Fundus photo; 45° FOV.
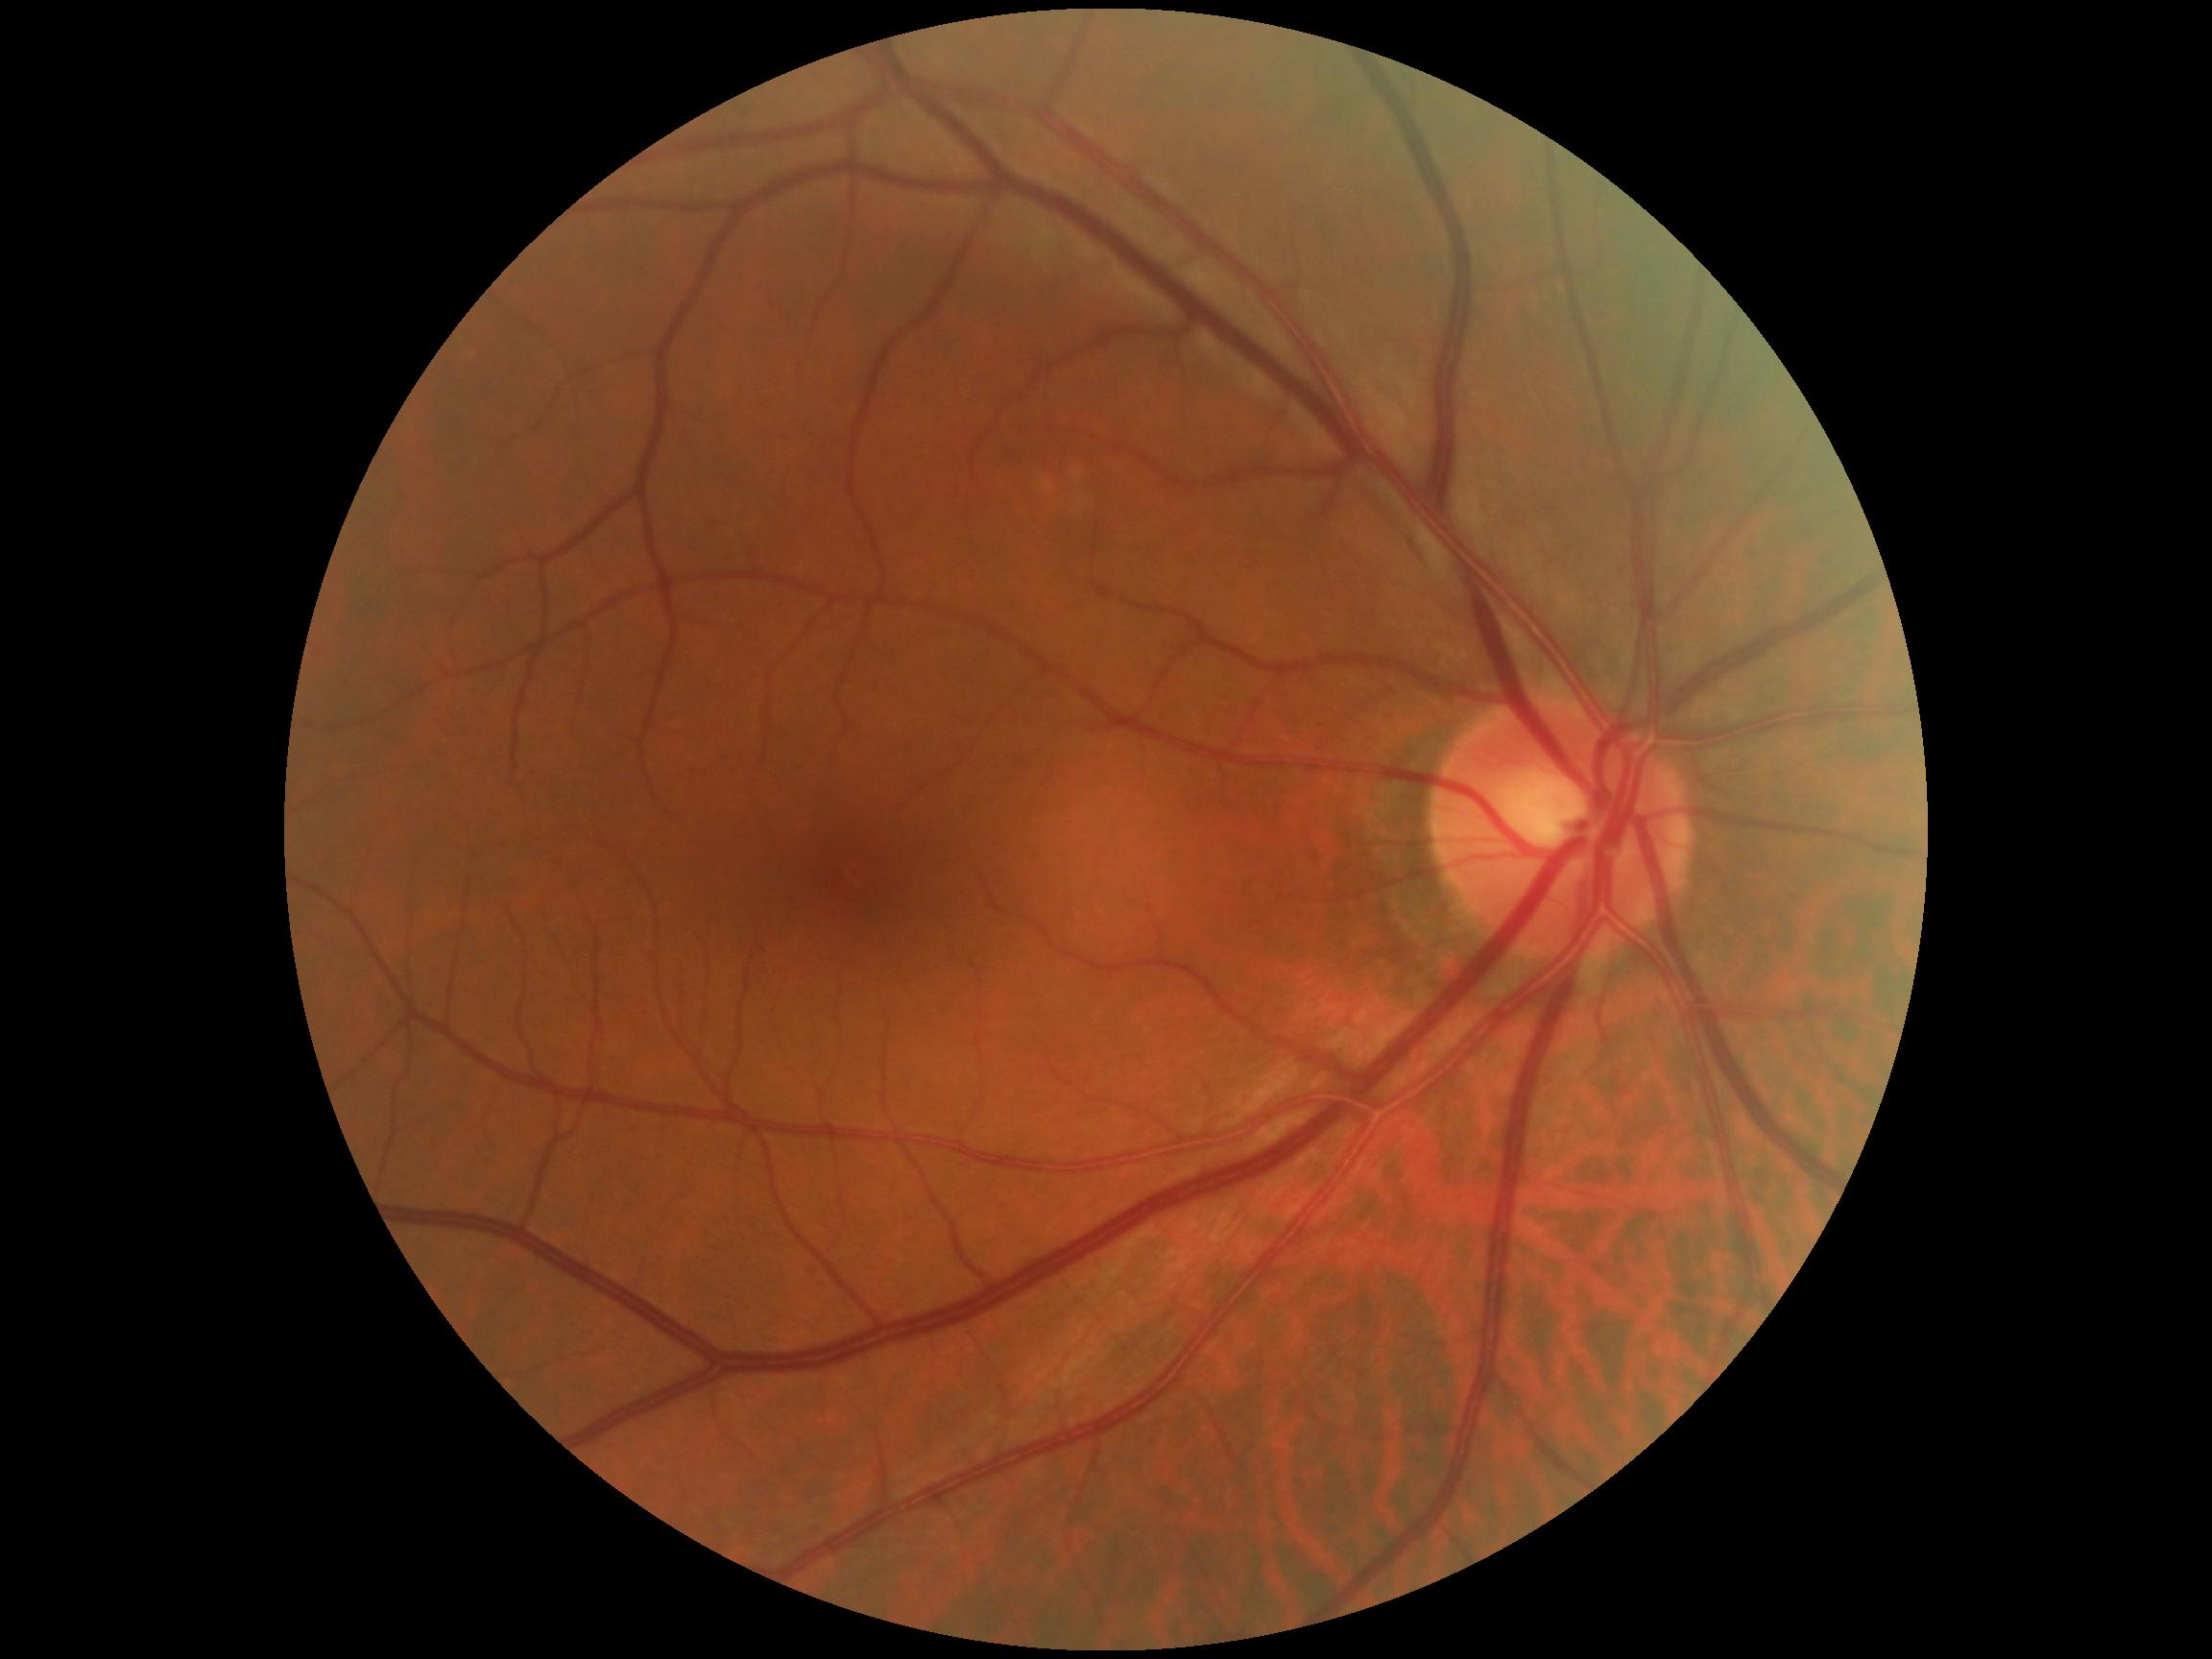
No signs of diabetic retinopathy. DR is no apparent diabetic retinopathy (grade 0).